Camera: Topcon TRC-50DX · dilated-pupil acquisition · retinal fundus photograph.
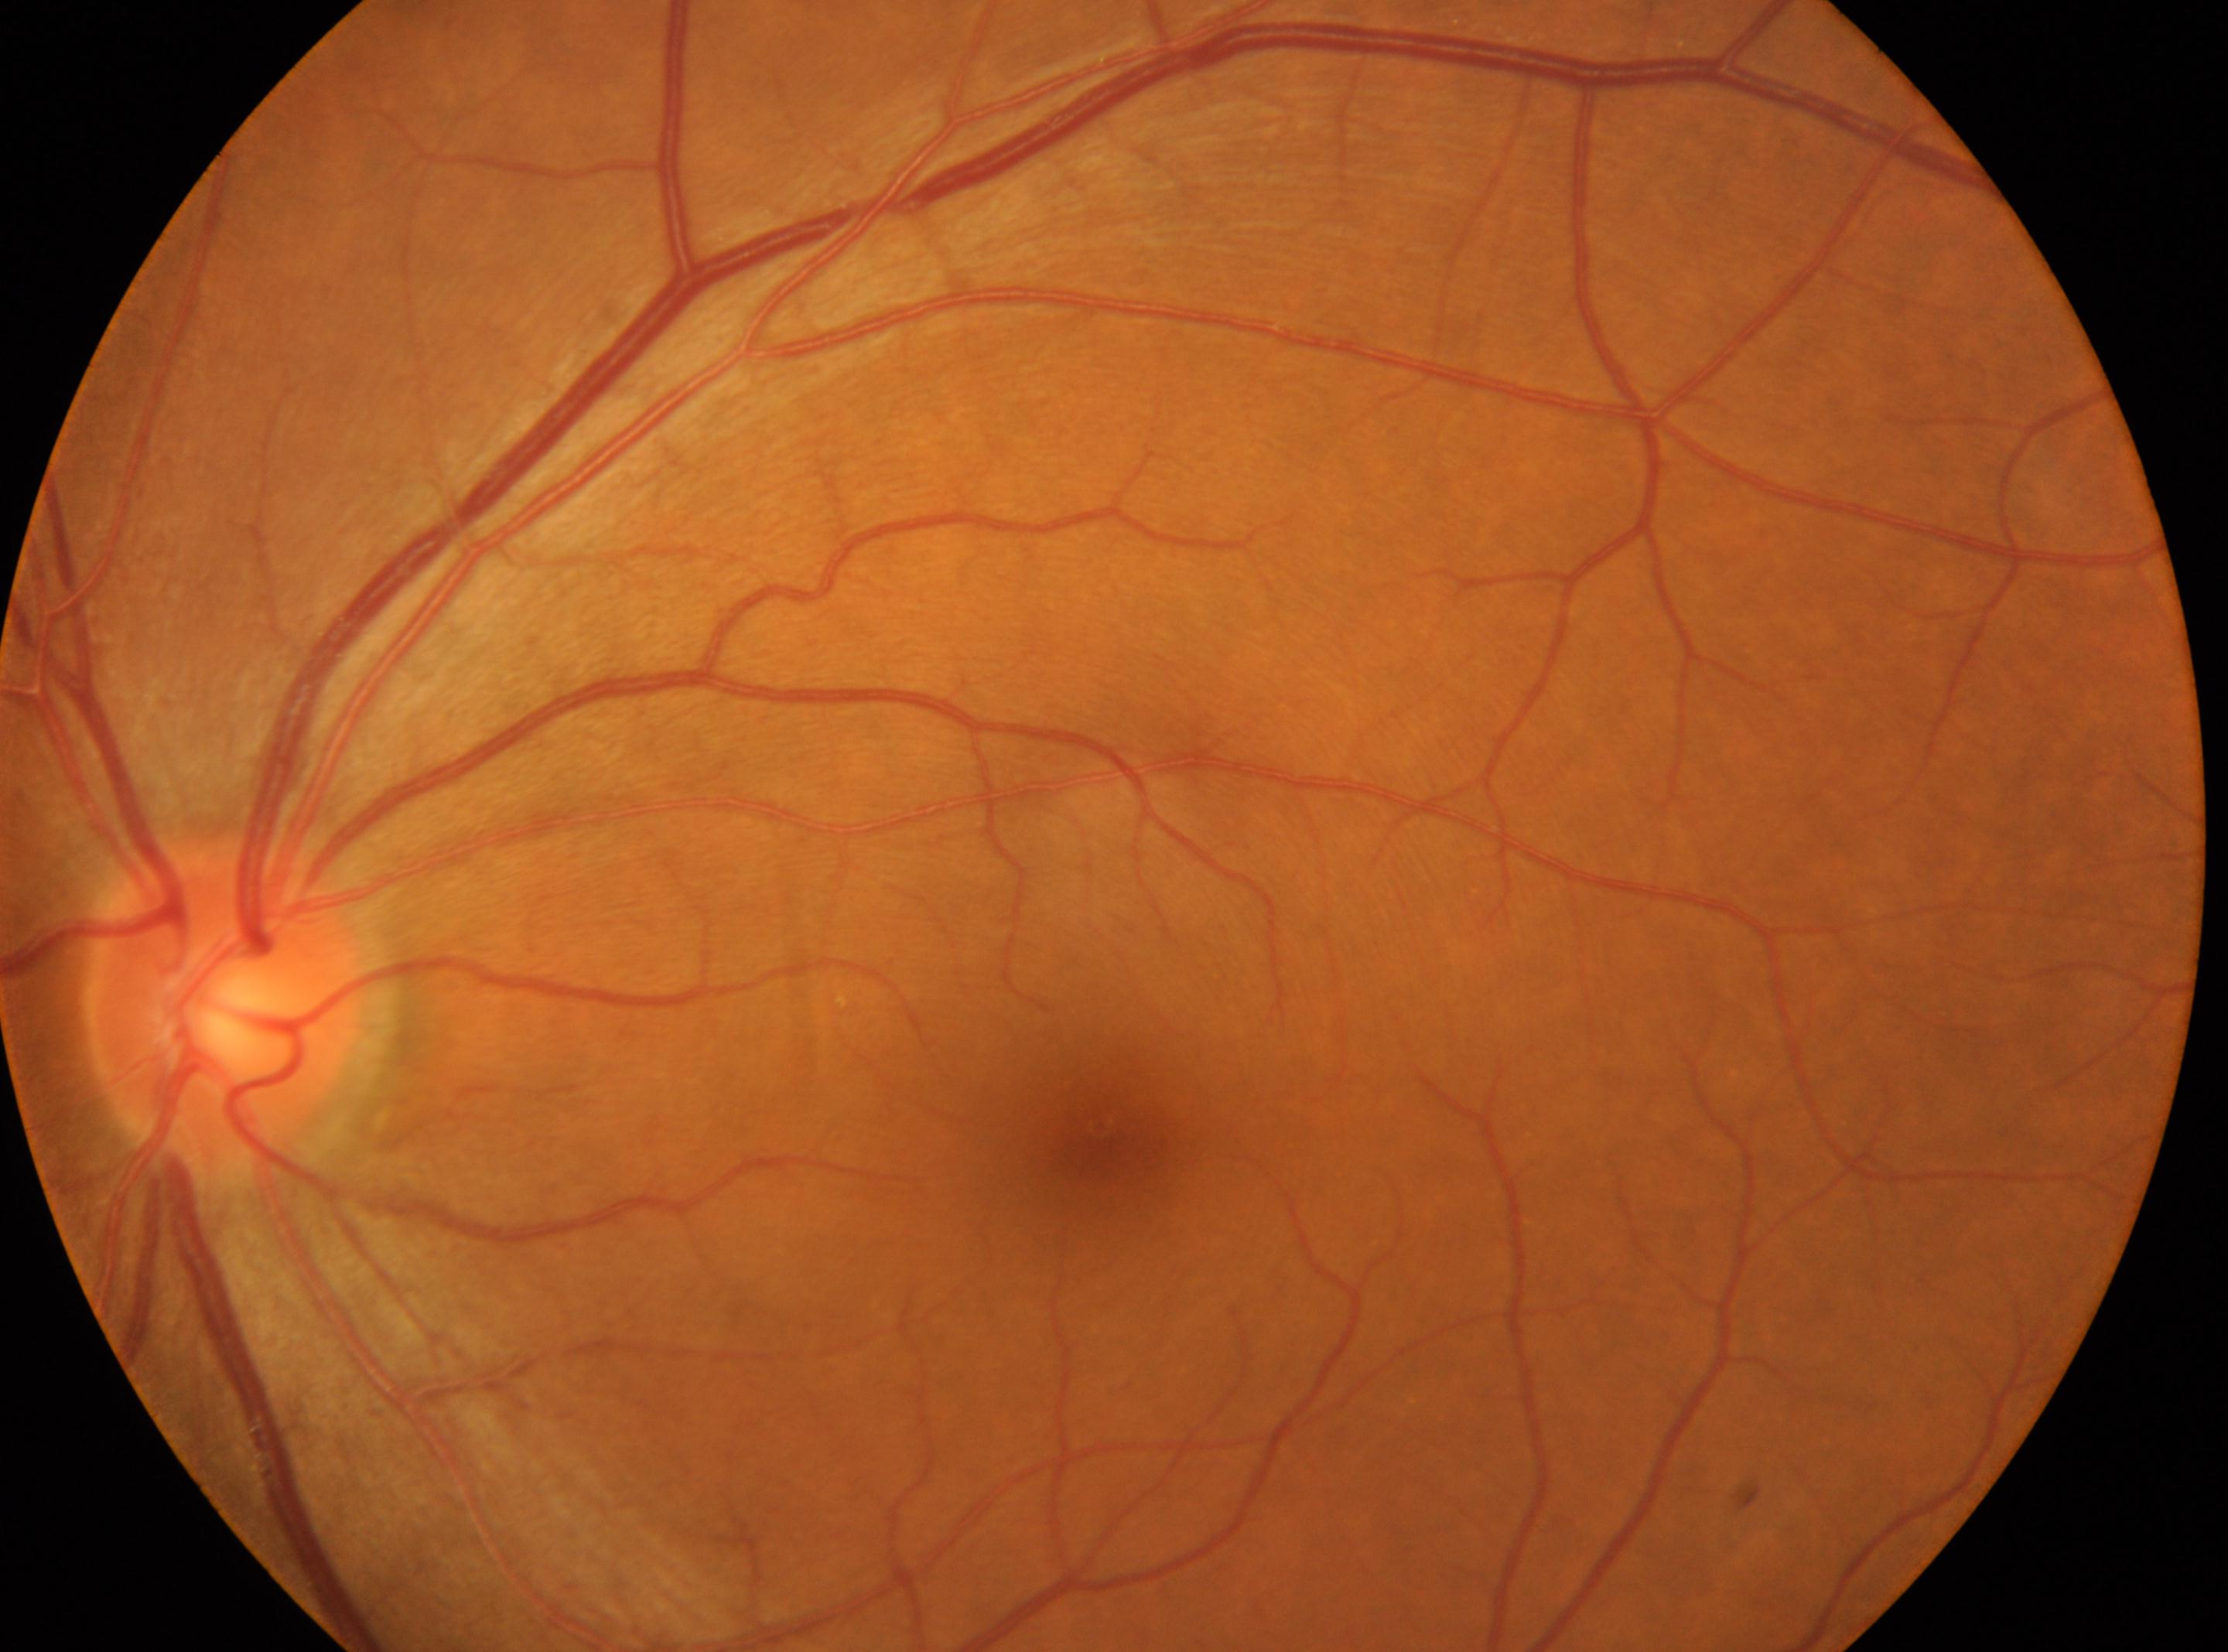

No apparent diabetic retinopathy.
Eye: oculus sinister.
Diabetic retinopathy is grade 0 (no apparent retinopathy).
Optic disc center located at (x=224, y=1004).
Macula center located at (x=1102, y=1129).